30-degree field of view; corneal thickness 558 µm; axial length: 22.07 mm.
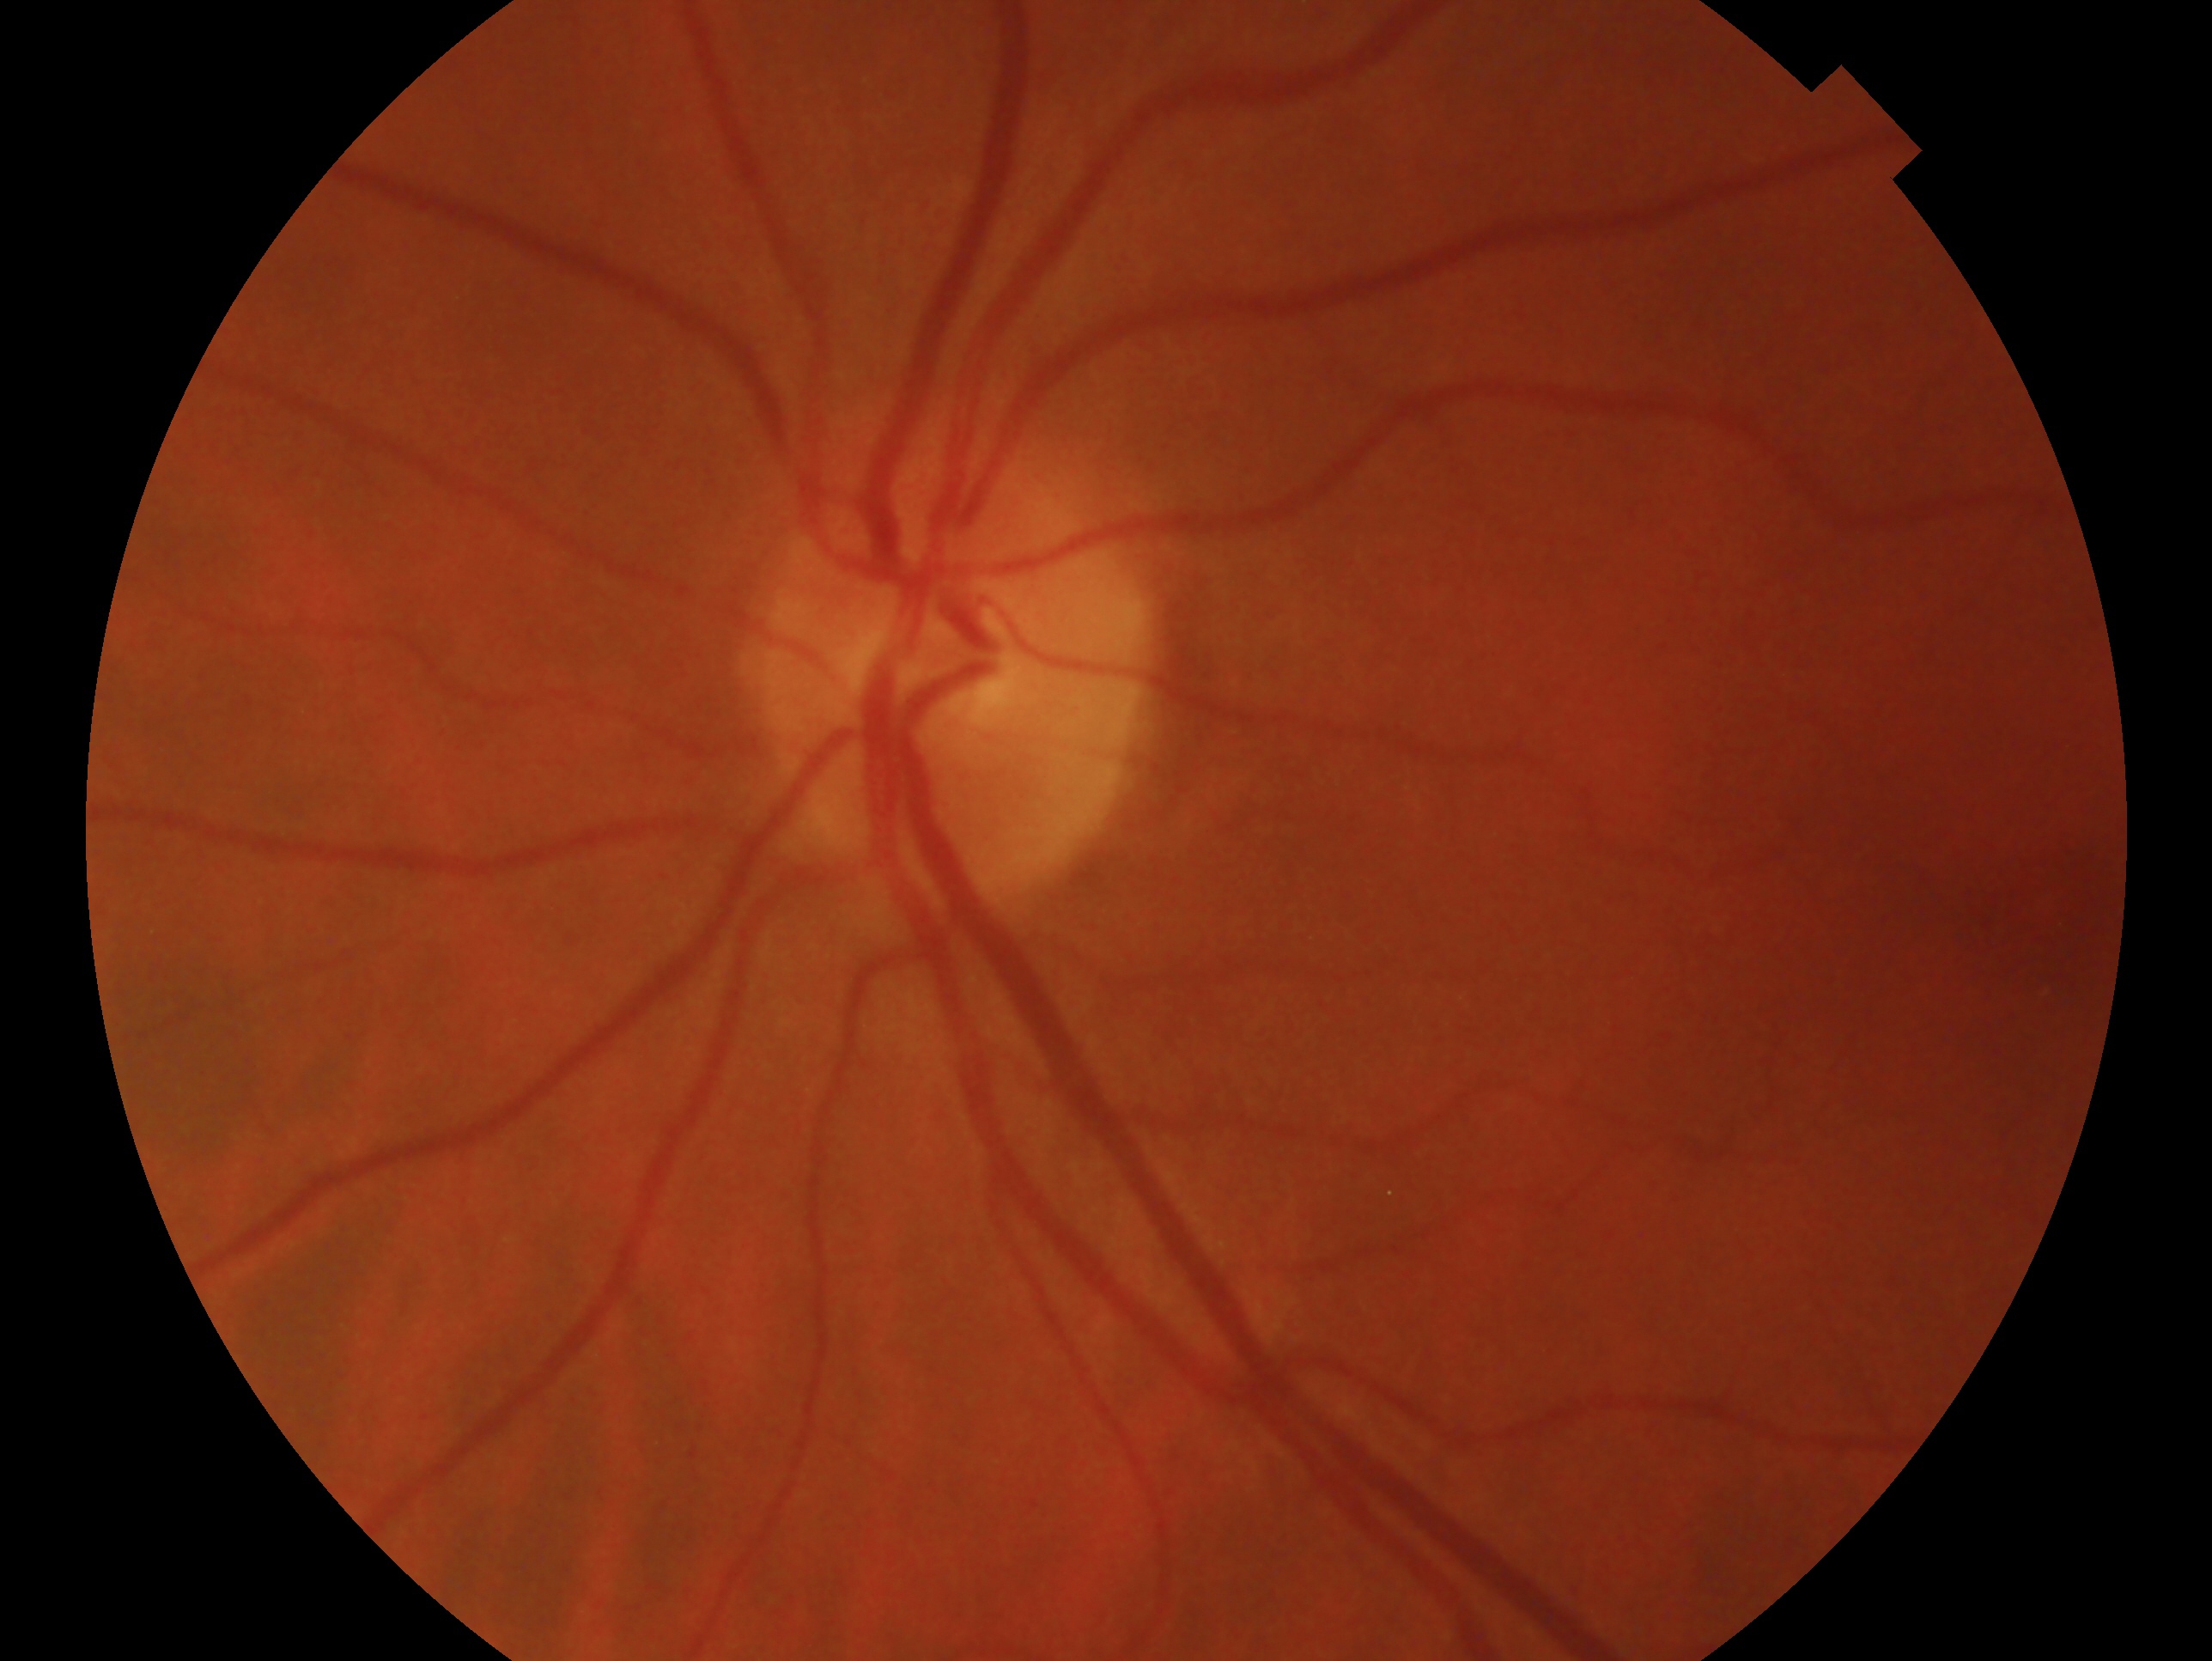
Imaged eye: left. Glaucoma status — no glaucomatous findings.